Acquired with a Remidio FOP fundus camera; color fundus image.
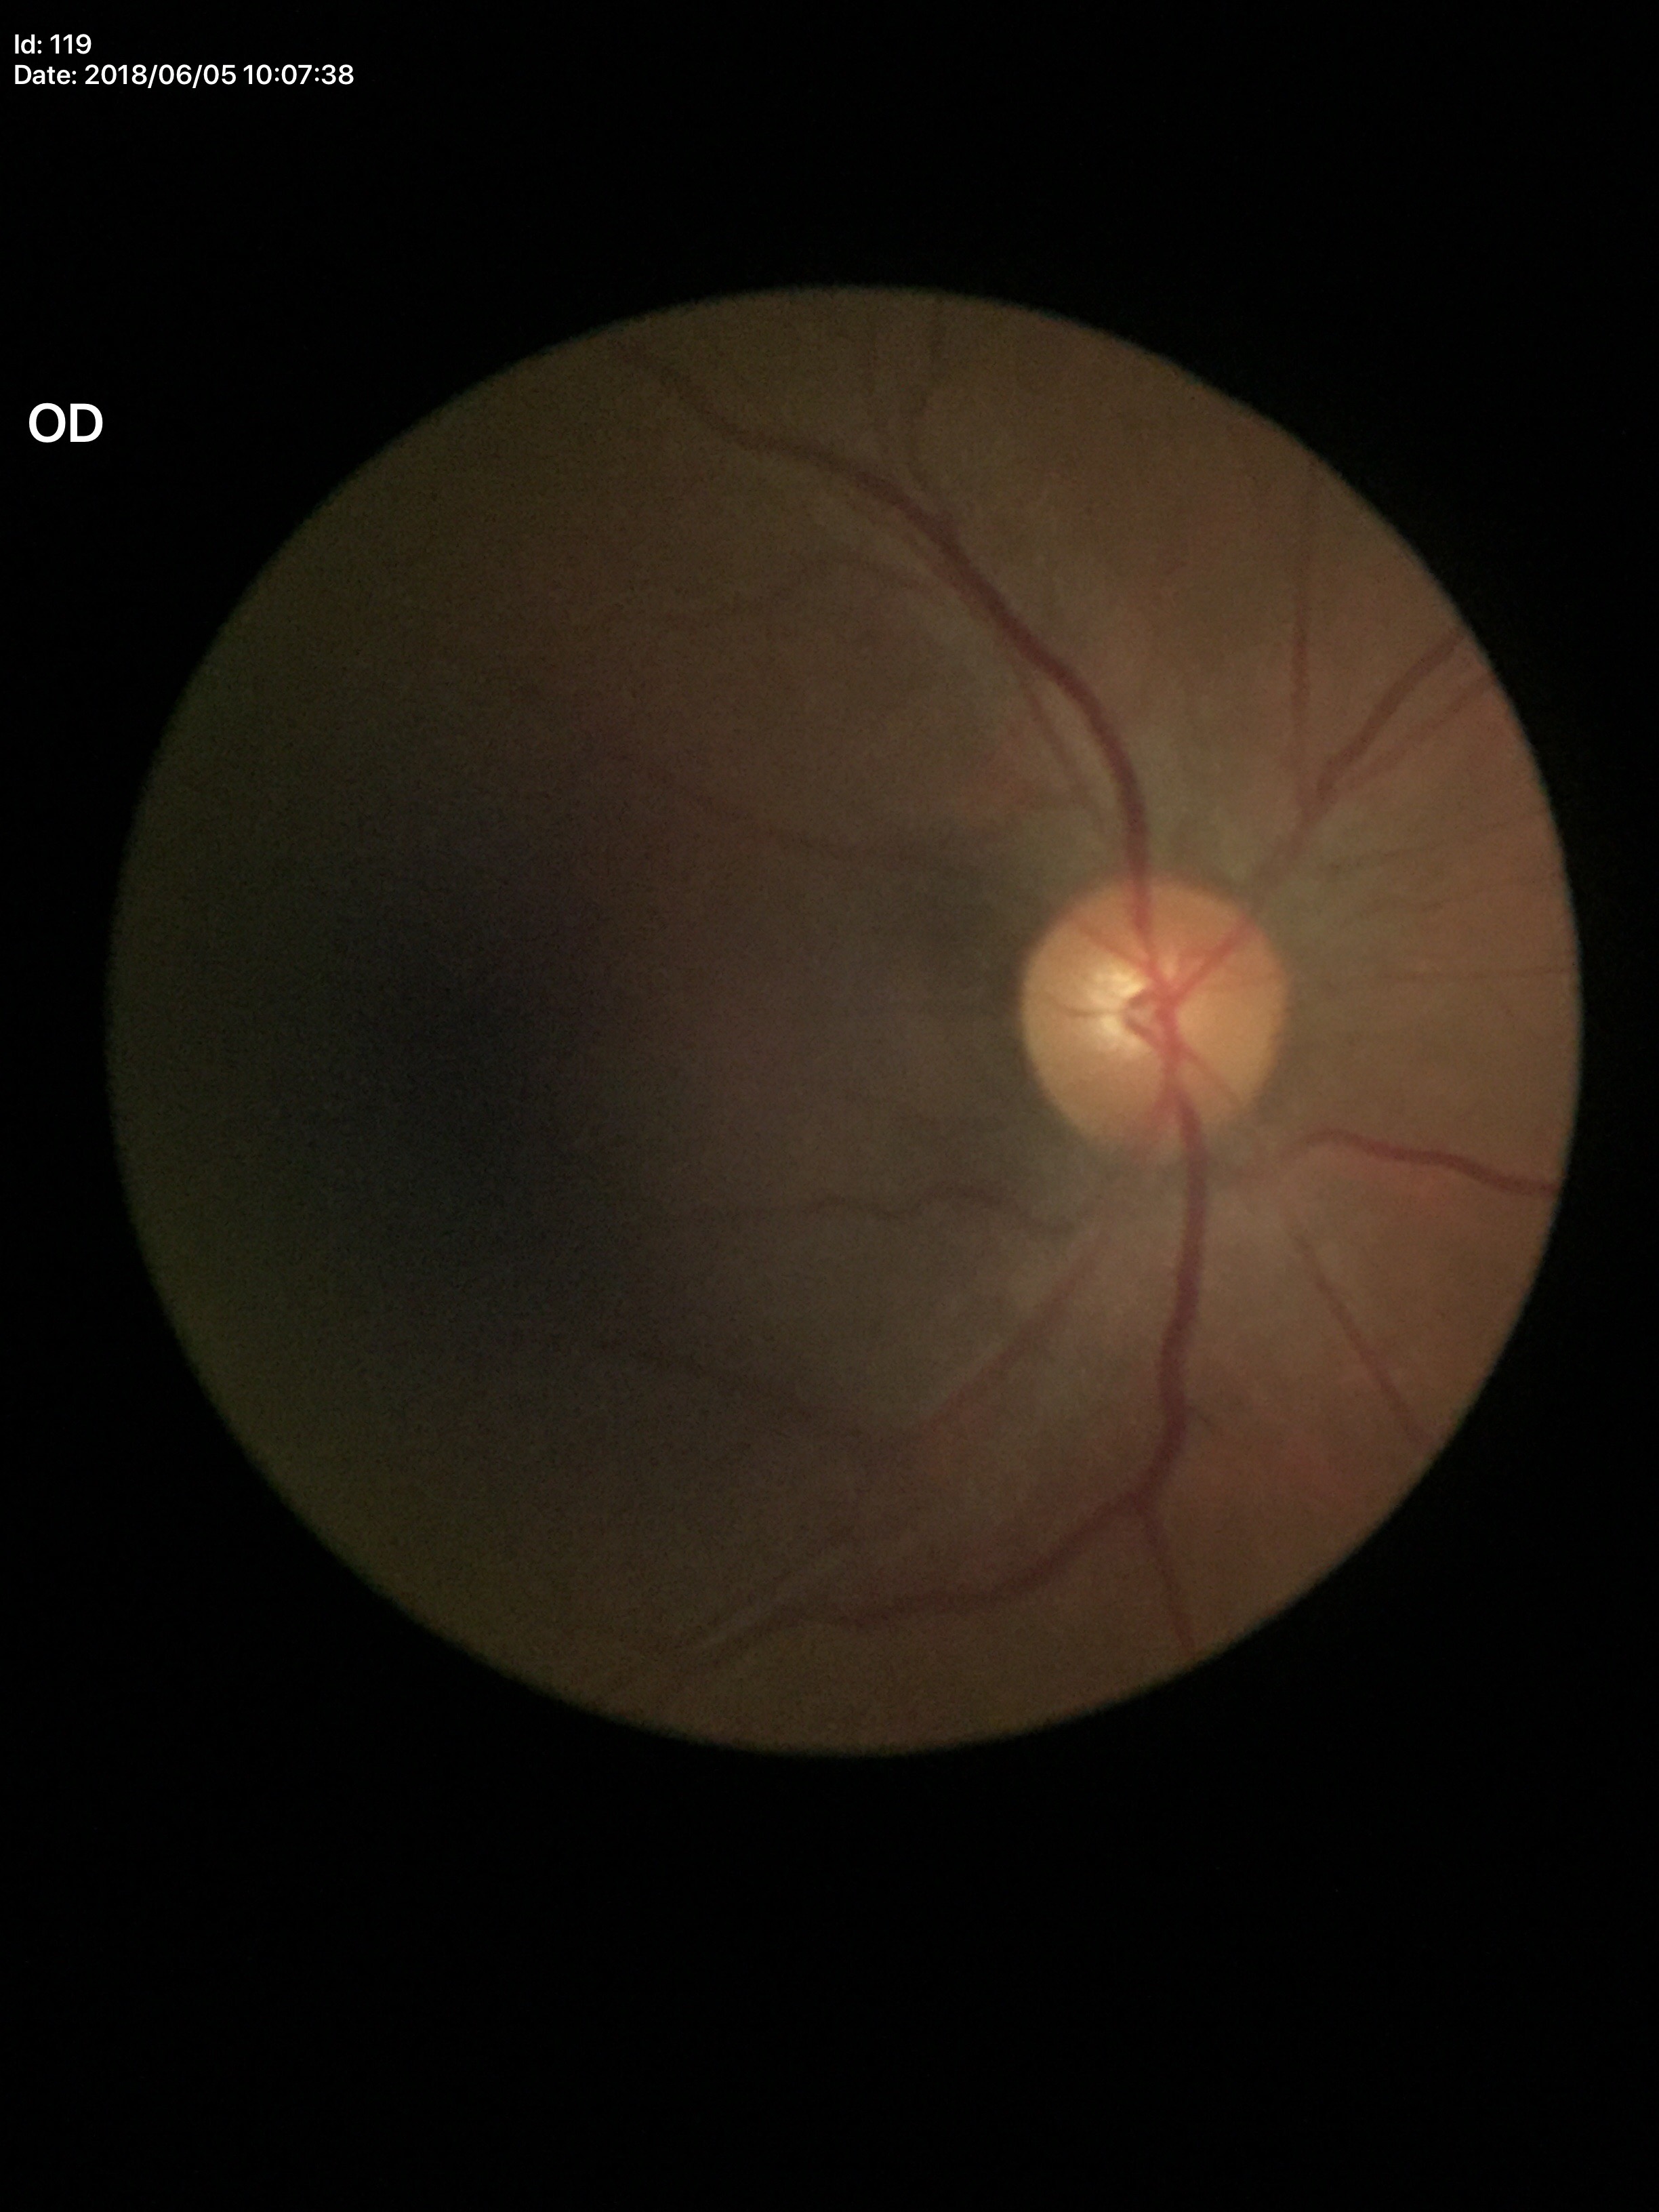

Horizontal cup-disc ratio of 0.46.
No glaucomatous optic neuropathy.
Vertical cup-to-disc ratio: 0.50.